Color fundus photograph: 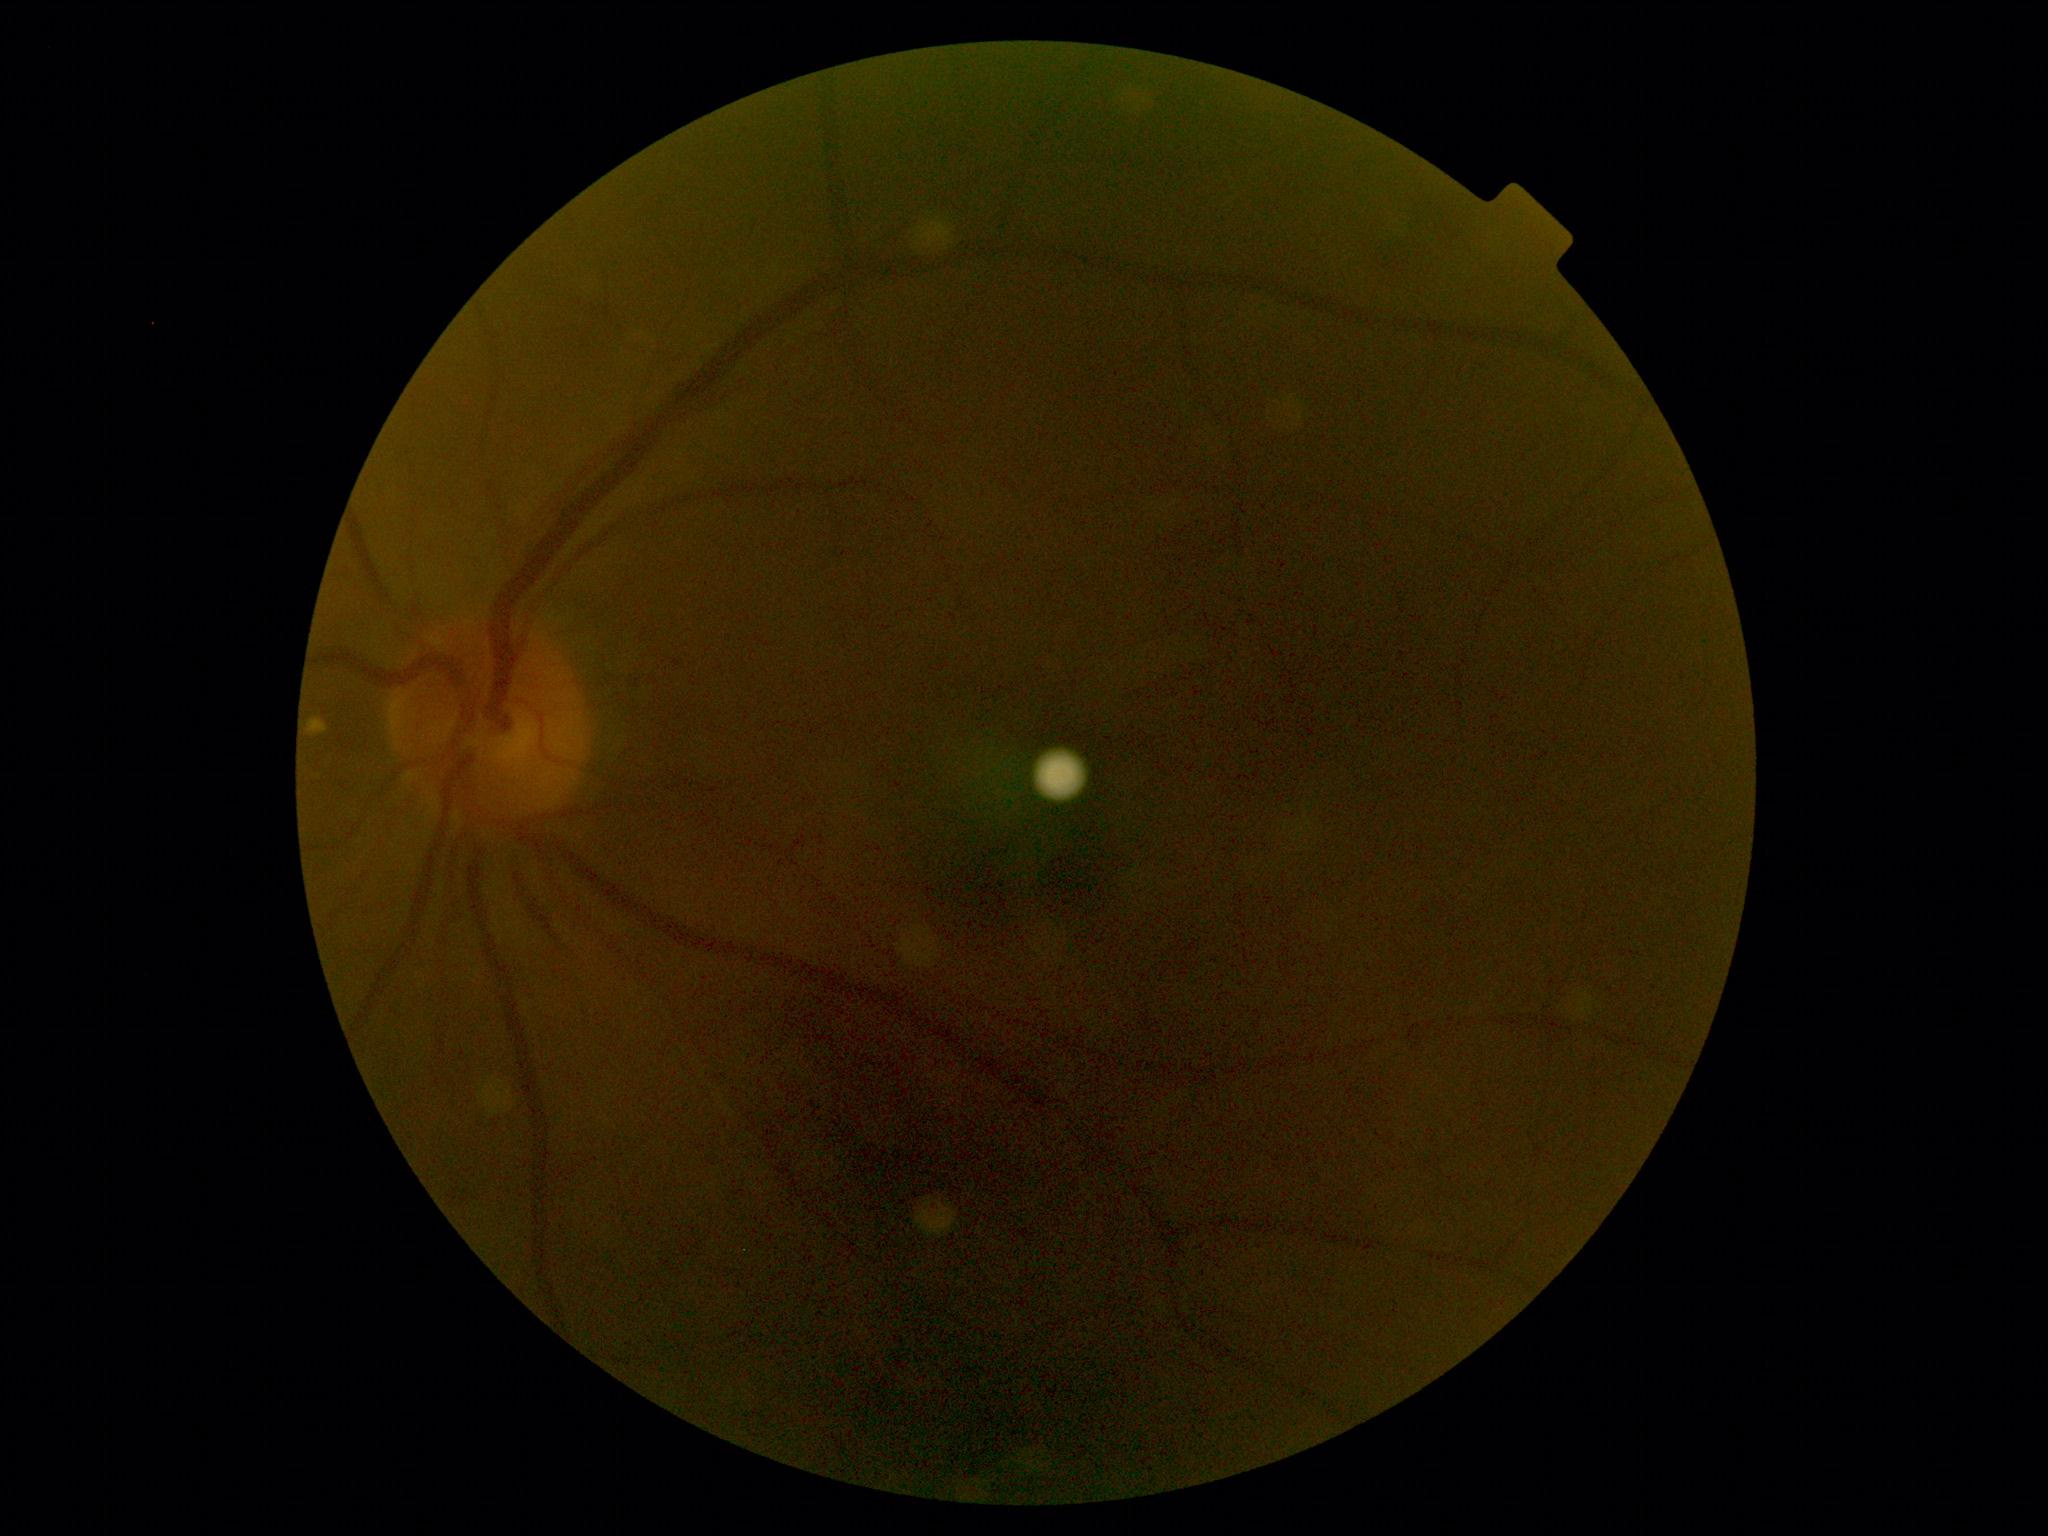
DR severity@0.